Macula at the center of the field · 2361x1568px · FOV: 50 degrees · color fundus image.
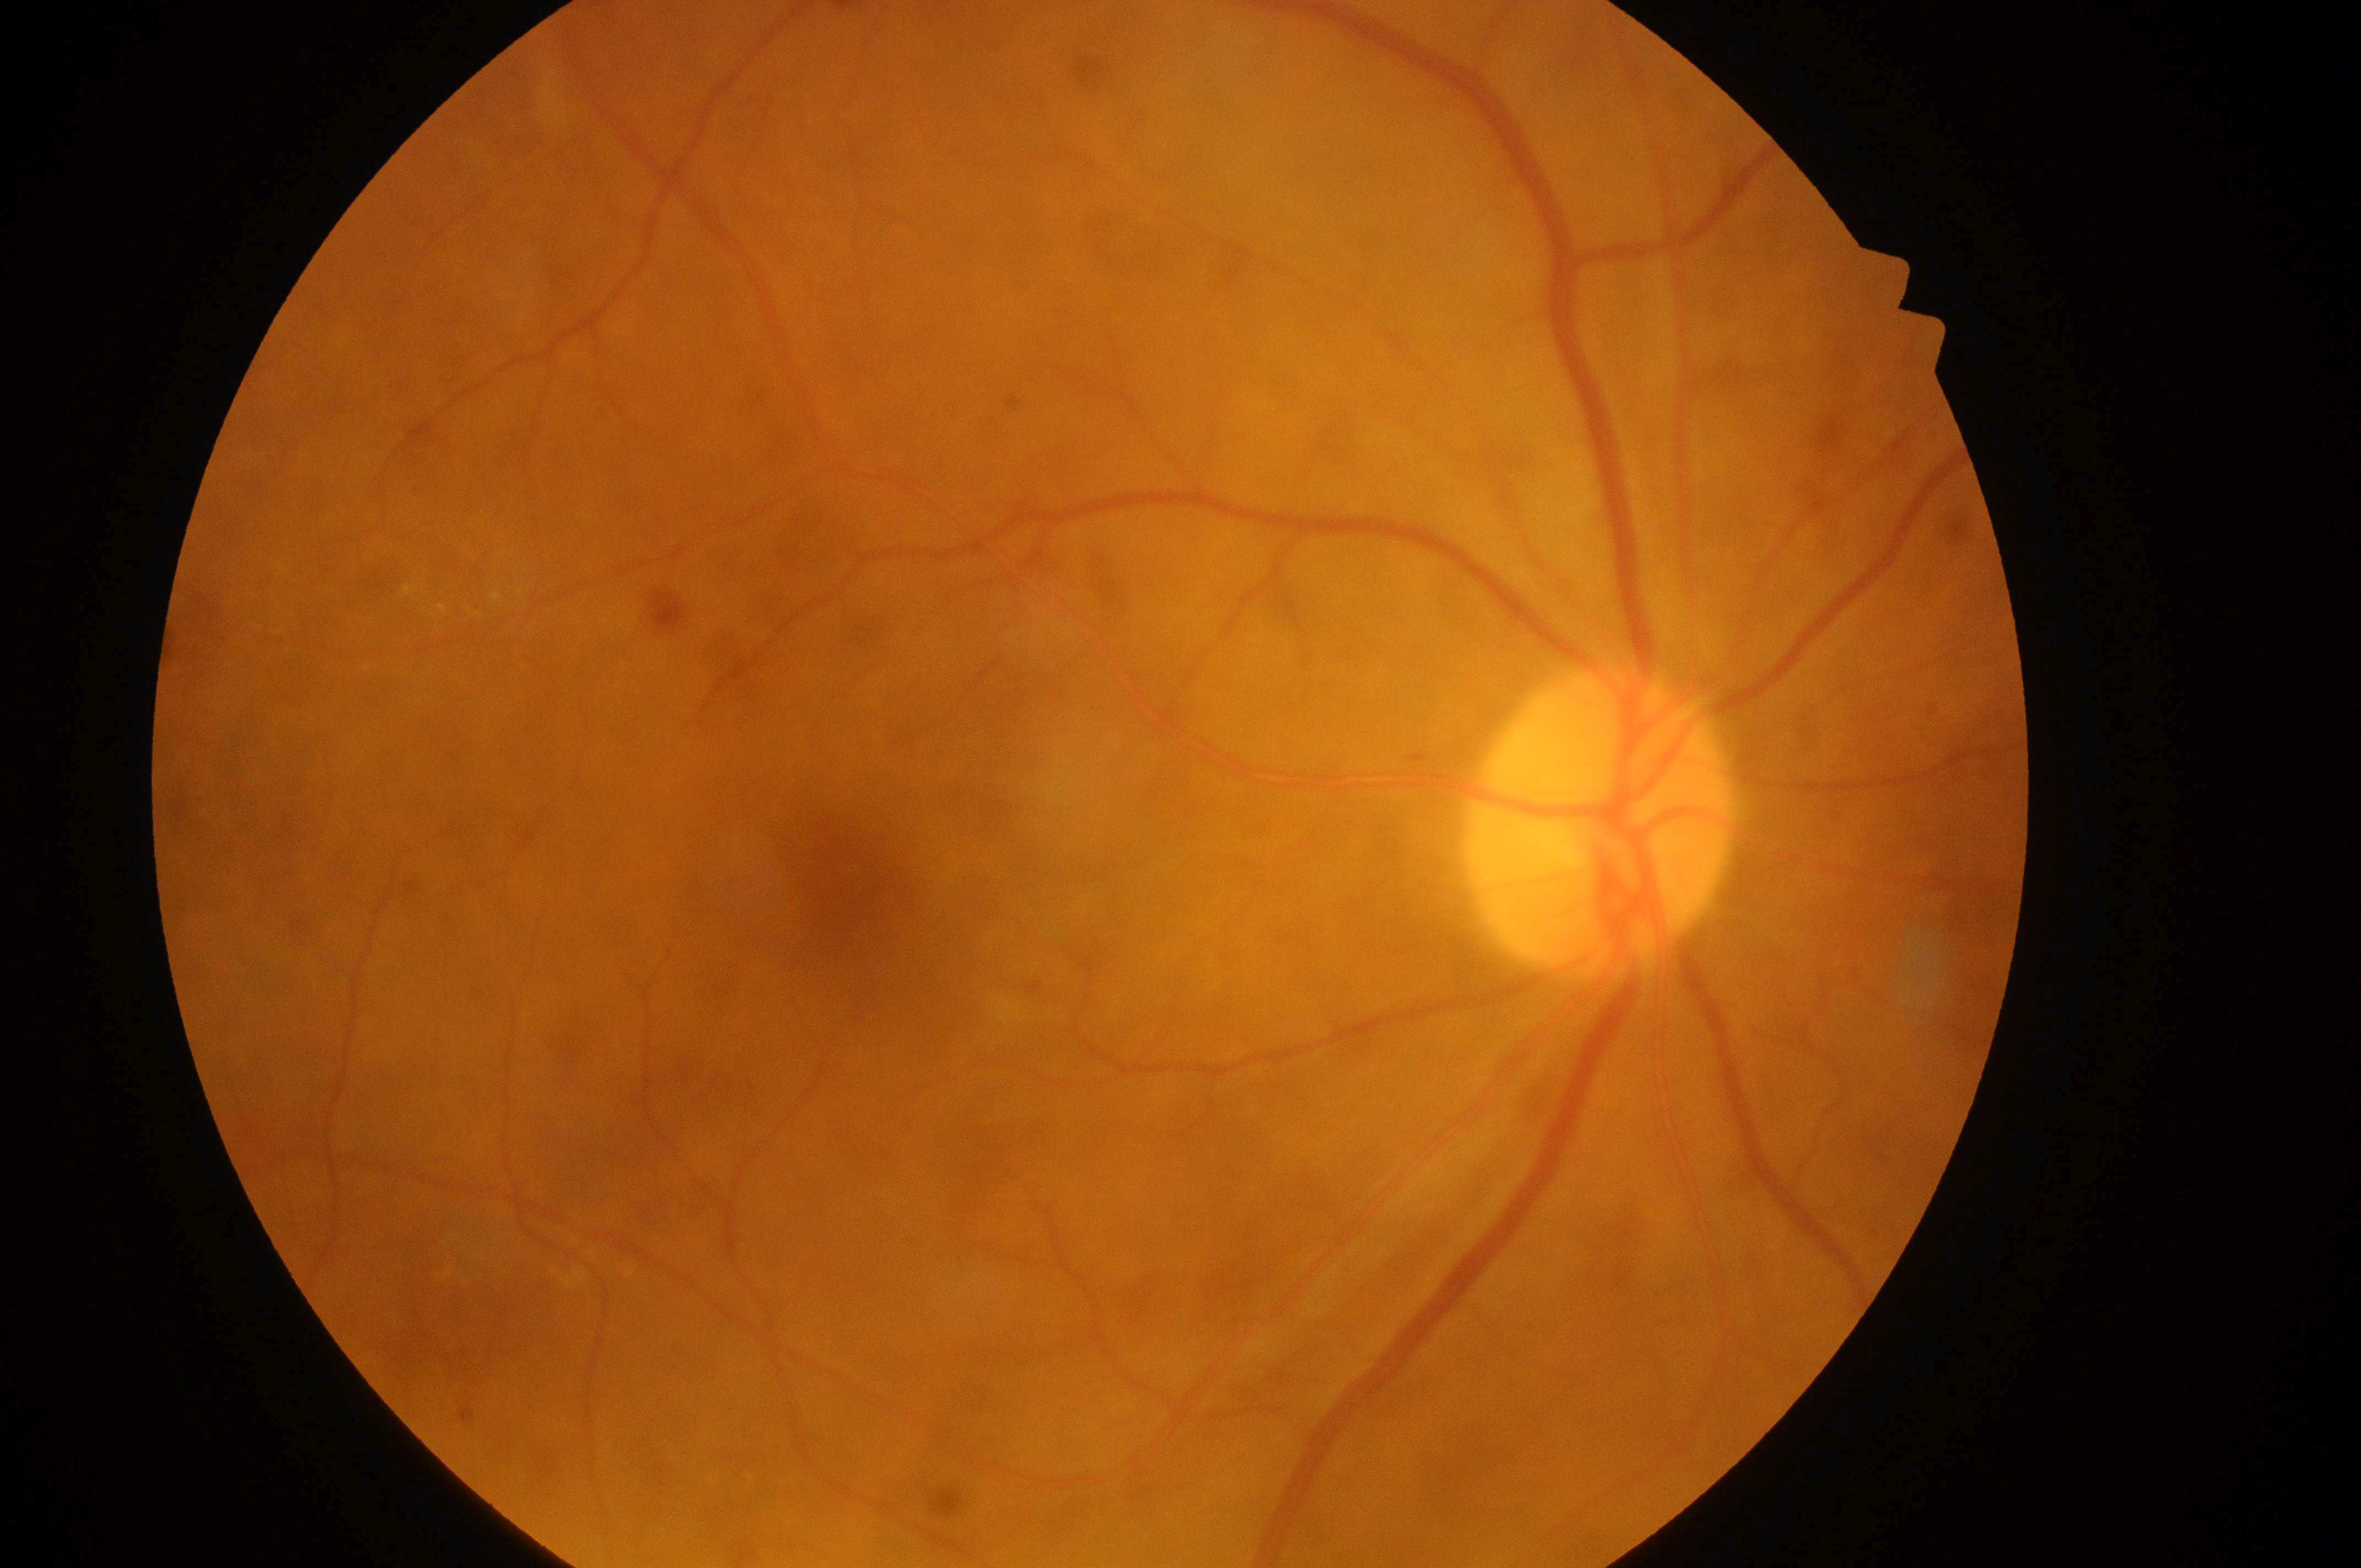
DME risk is low risk (grade 1).
Optic disk: 1597px, 835px.
Foveal center located at 846px, 889px.
DR grade: 2 (moderate NPDR).
This is the oculus dexter.